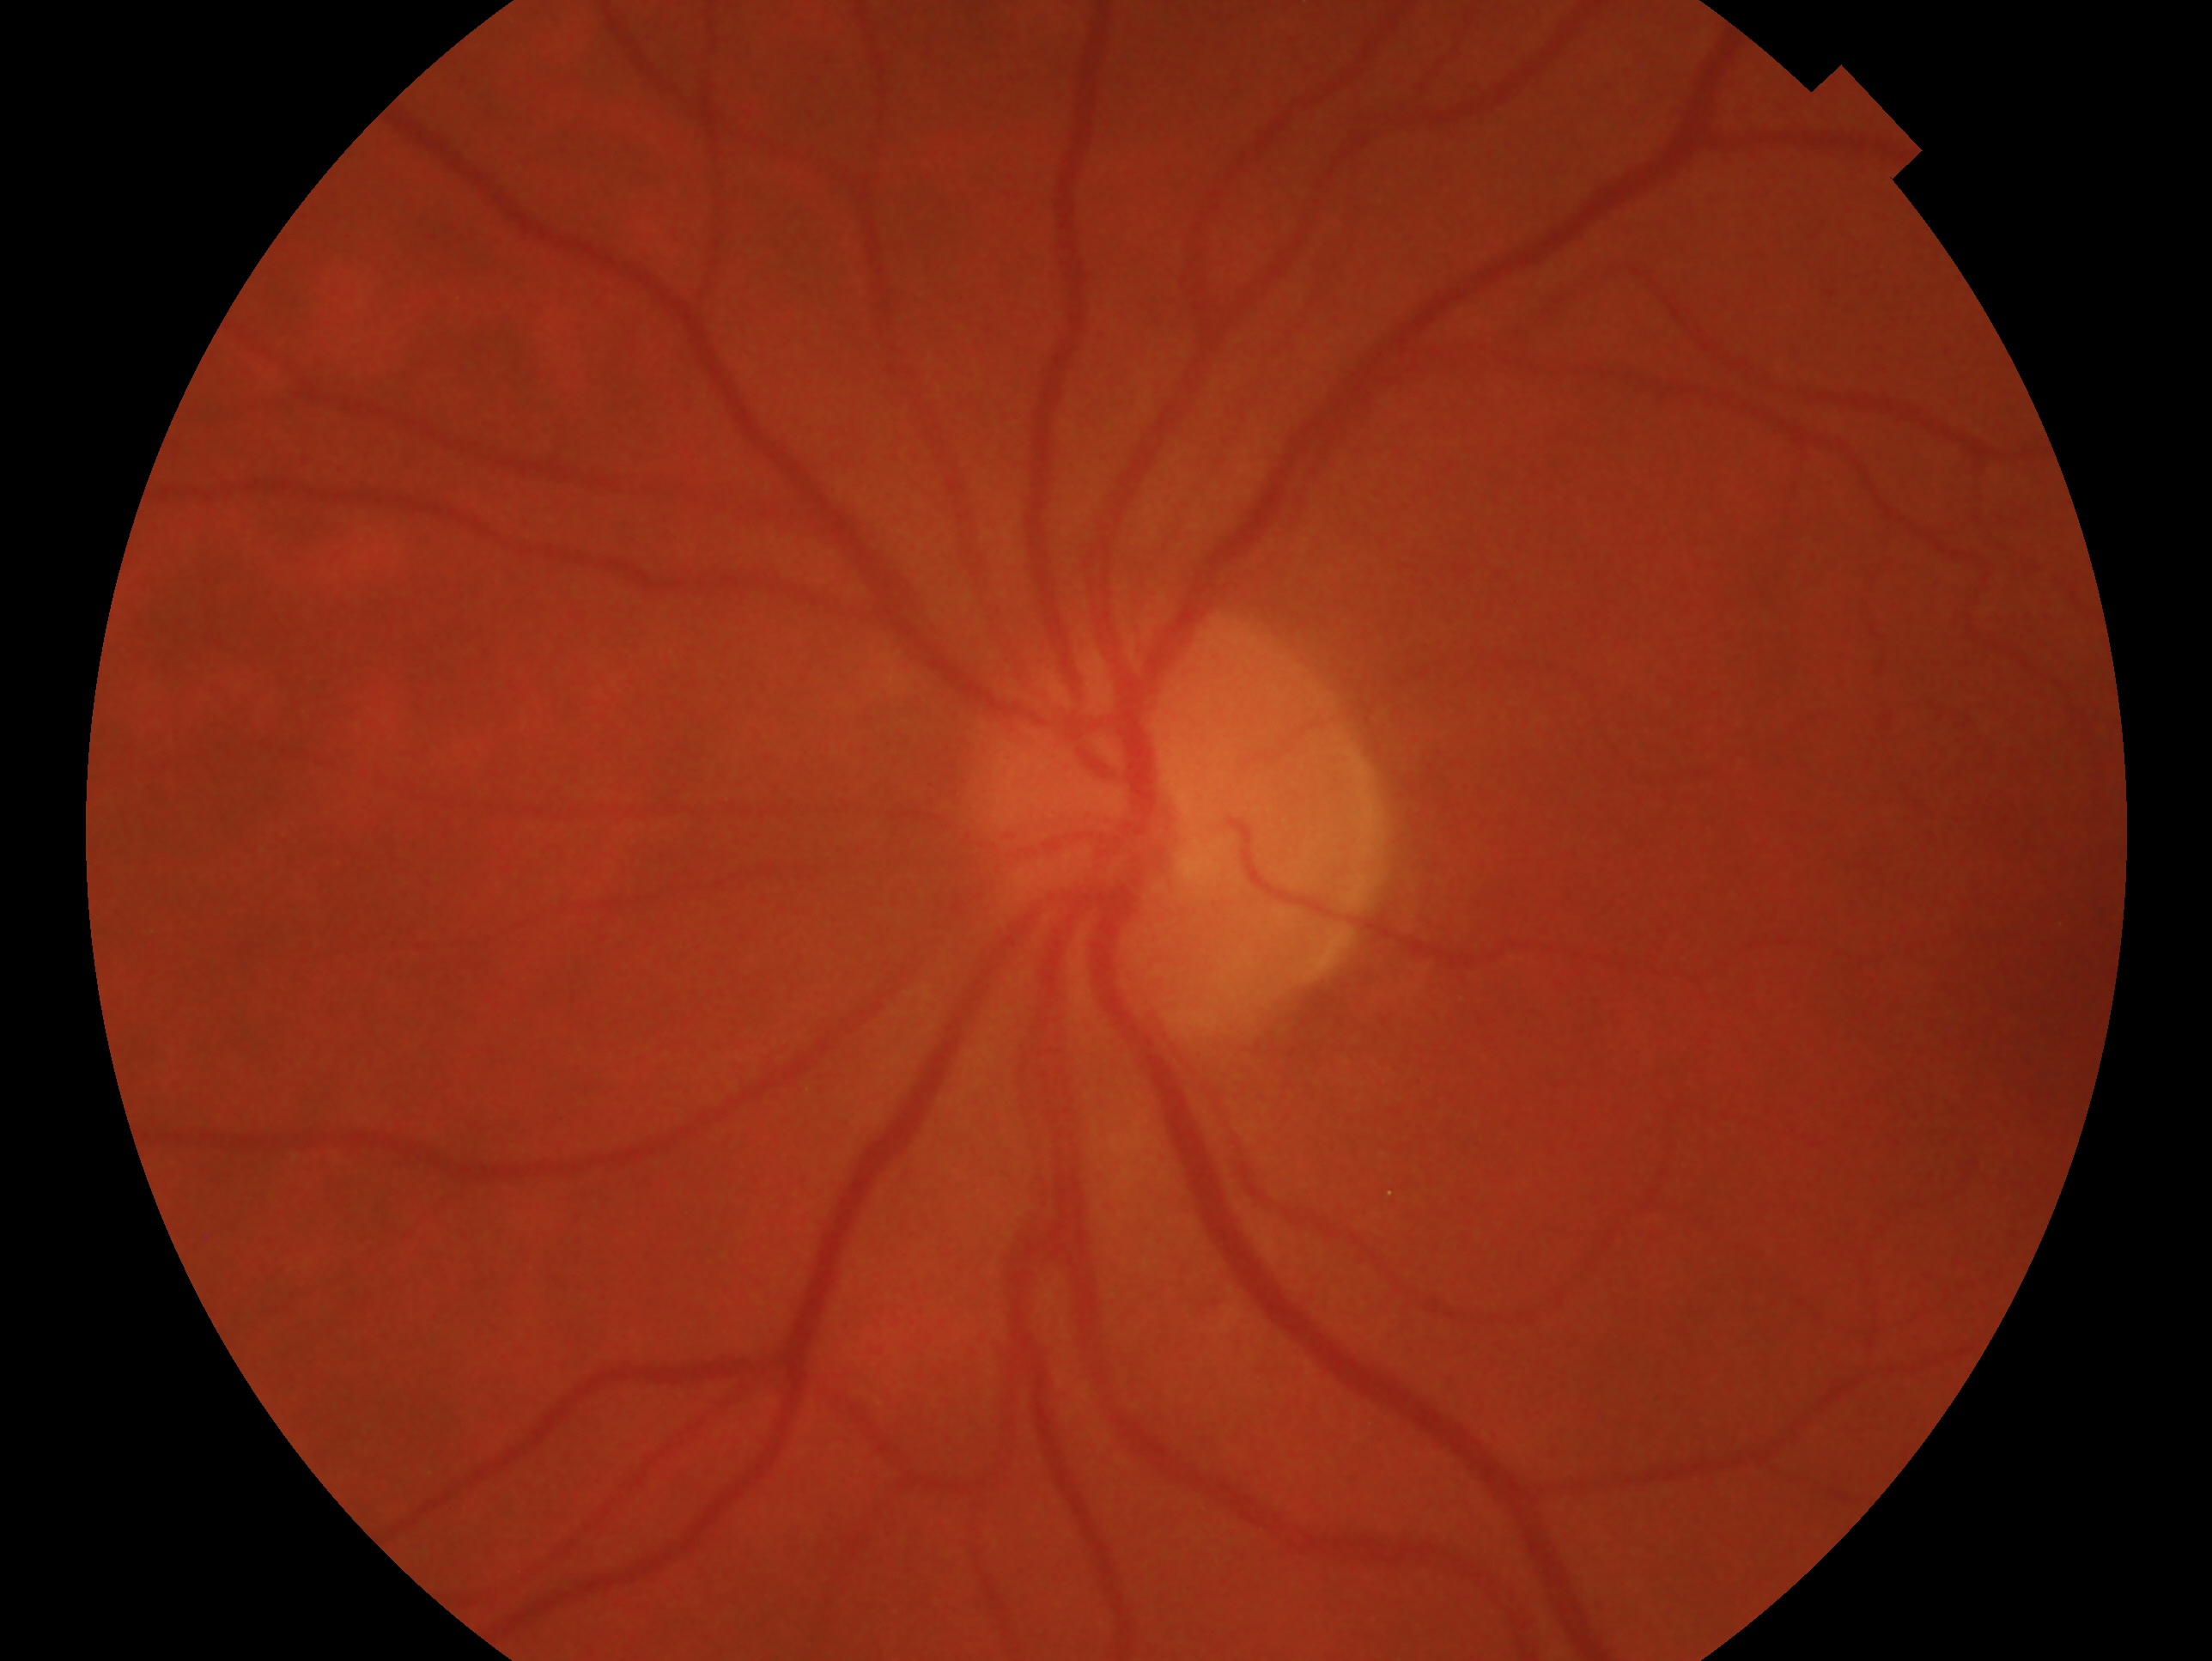

Diagnosis: no glaucoma. The image shows the OS.